Camera: NIDEK AFC-230: 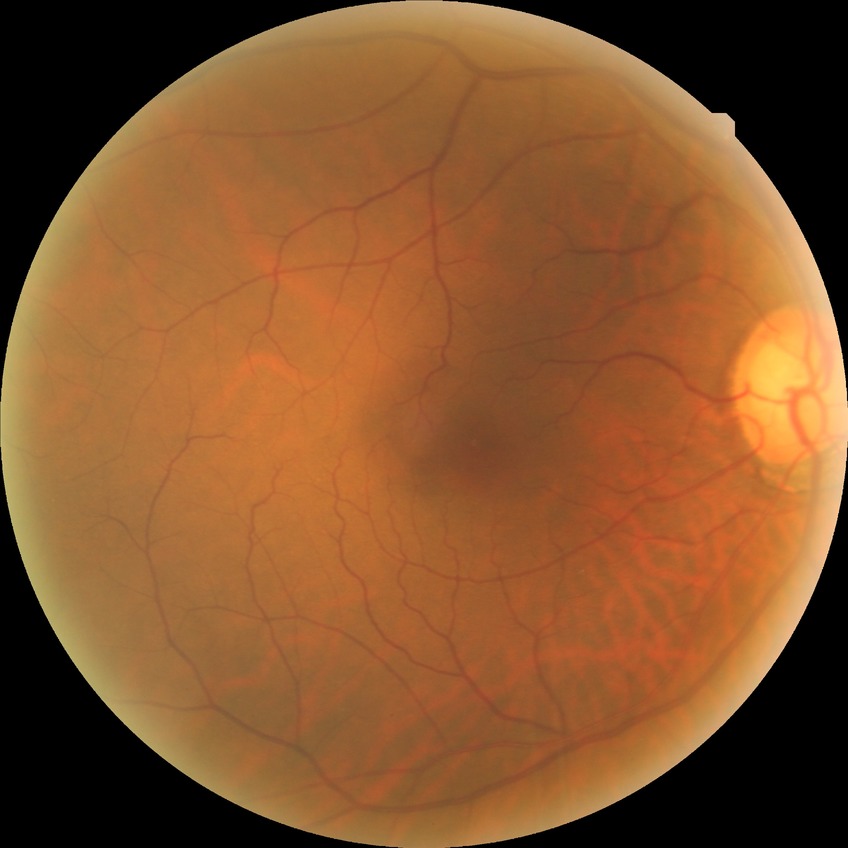

{
  "davis_grade": "no diabetic retinopathy (NDR)"
}